Diabetic retinopathy graded by the modified Davis classification:
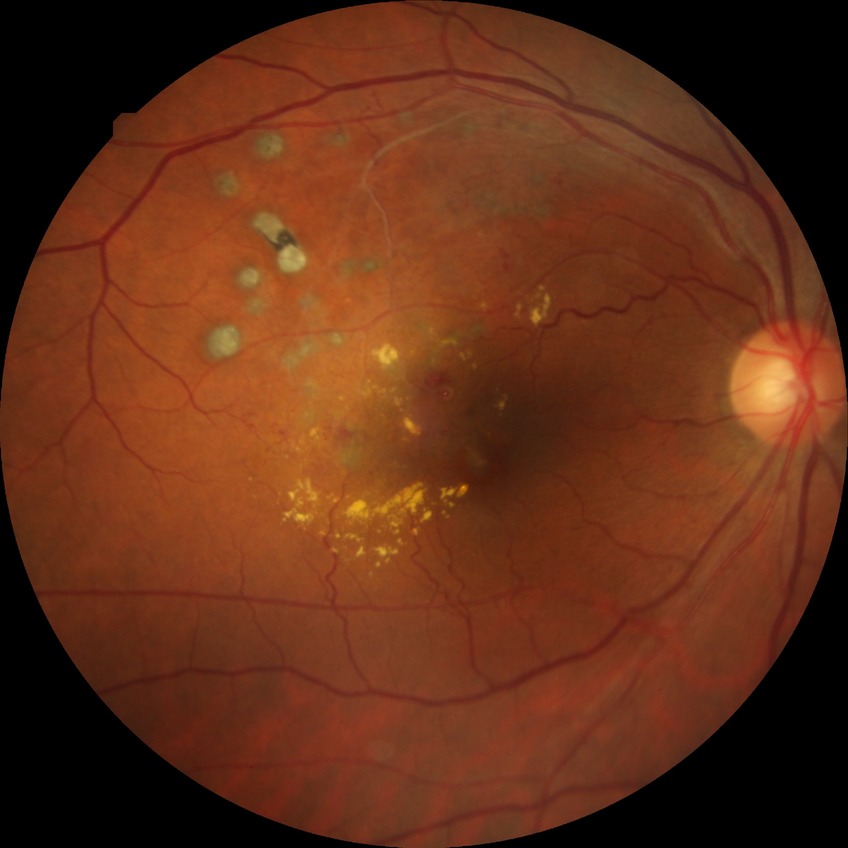
  davis_grade: no diabetic retinopathy